Wide-field fundus photograph of an infant · acquired on the Clarity RetCam 3.
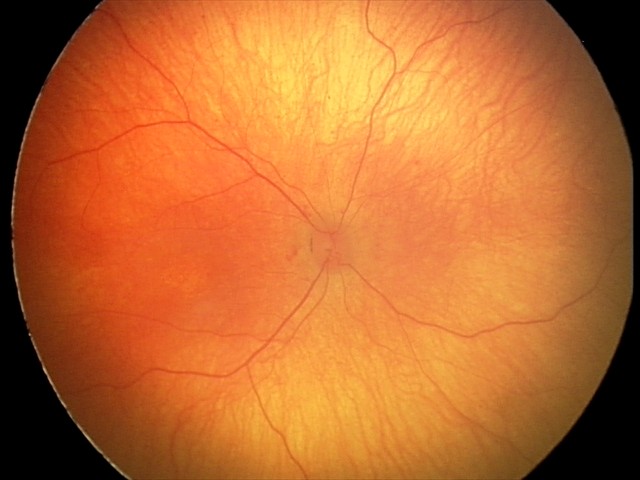
Screening diagnosis = physiological appearance.